640 by 480 pixels. Wide-field fundus photograph from neonatal ROP screening.
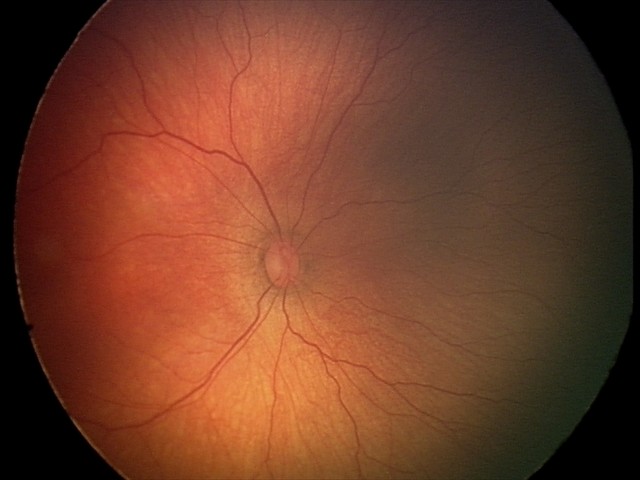 Plus disease absent. Screening examination consistent with ROP stage 2.